Nonmydriatic fundus photograph. Modified Davis classification. 848x848px
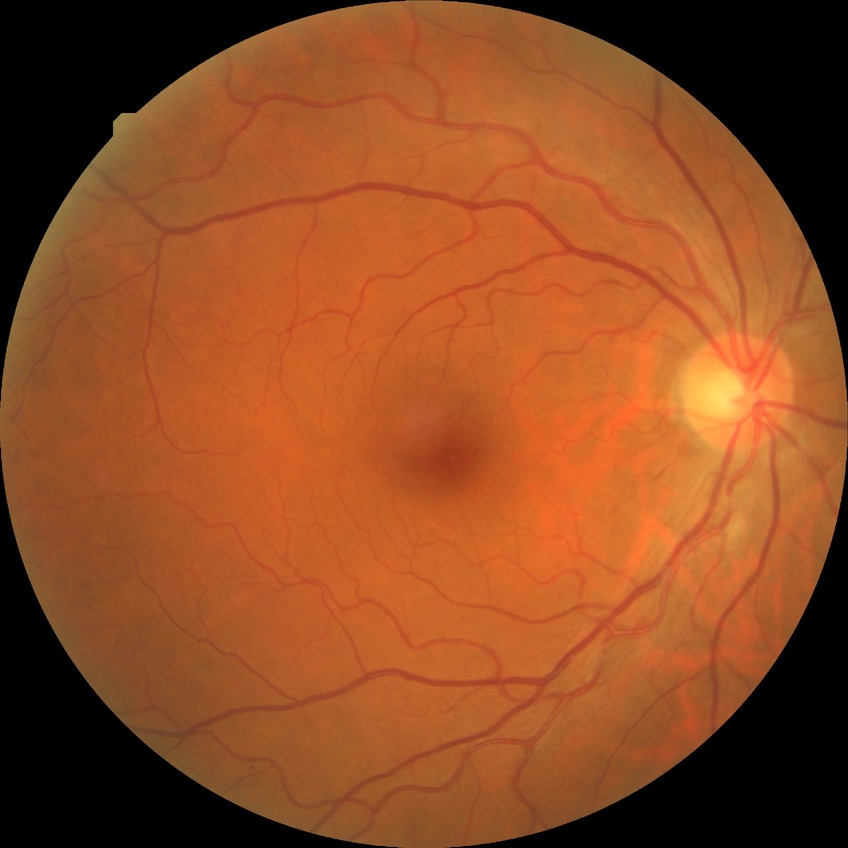

DR: NDR
DR impression: negative for DR